1440x1080px; 130° field of view (Natus RetCam Envision); wide-field fundus photograph of an infant
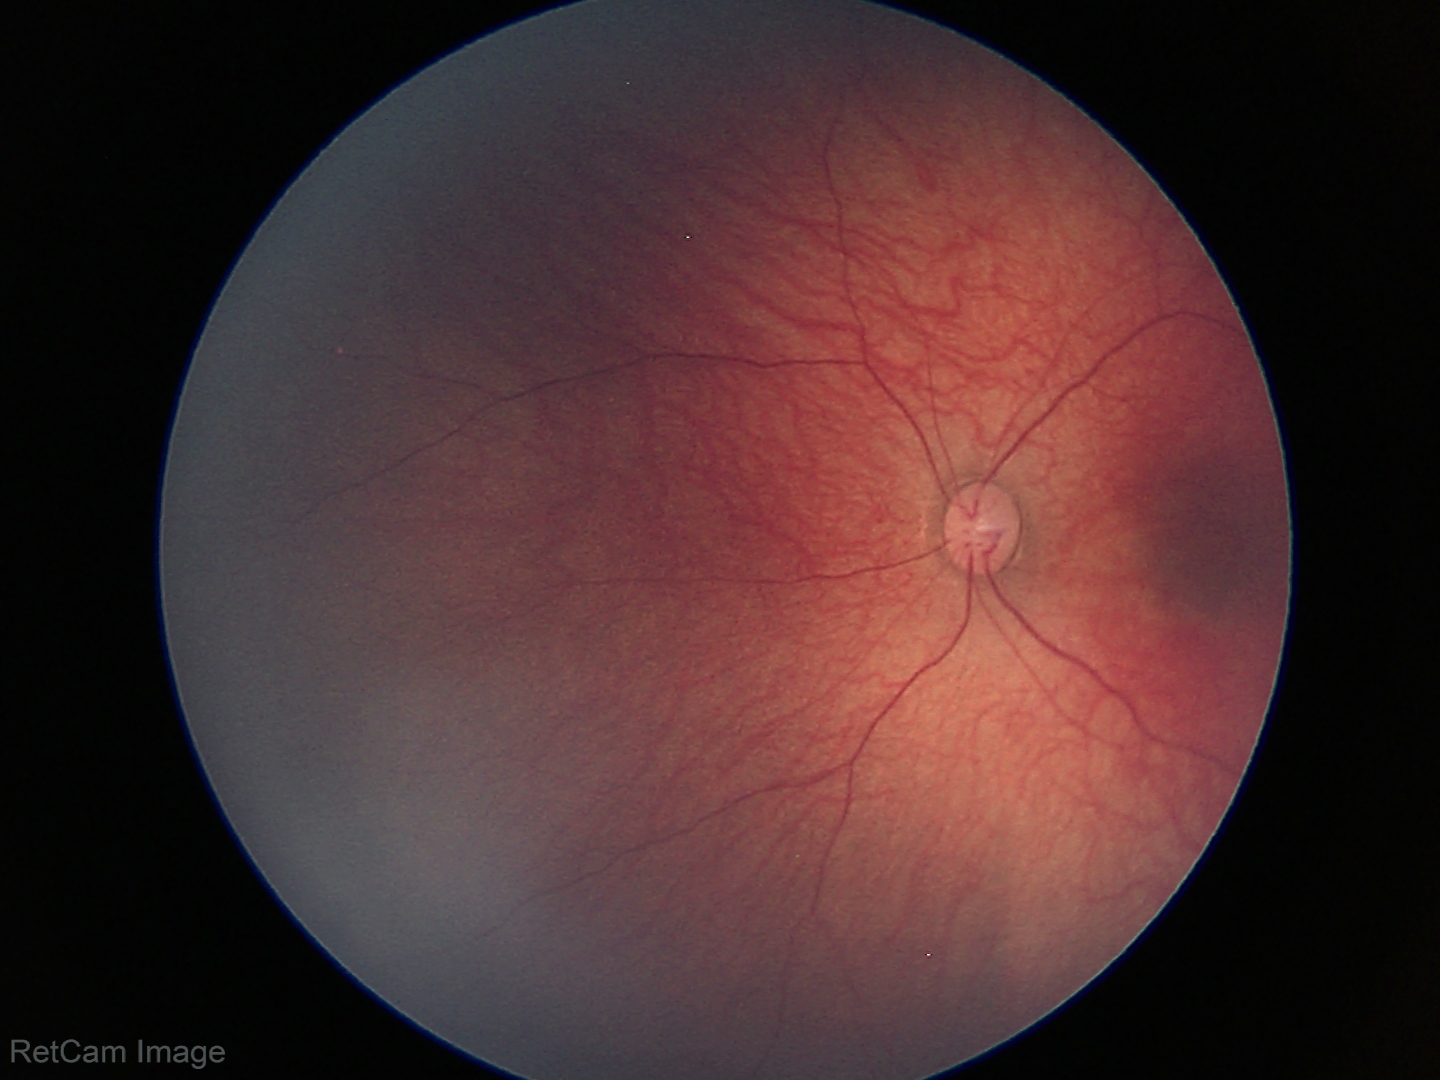
Screening examination with no abnormal retinal findings.